Fundus photo
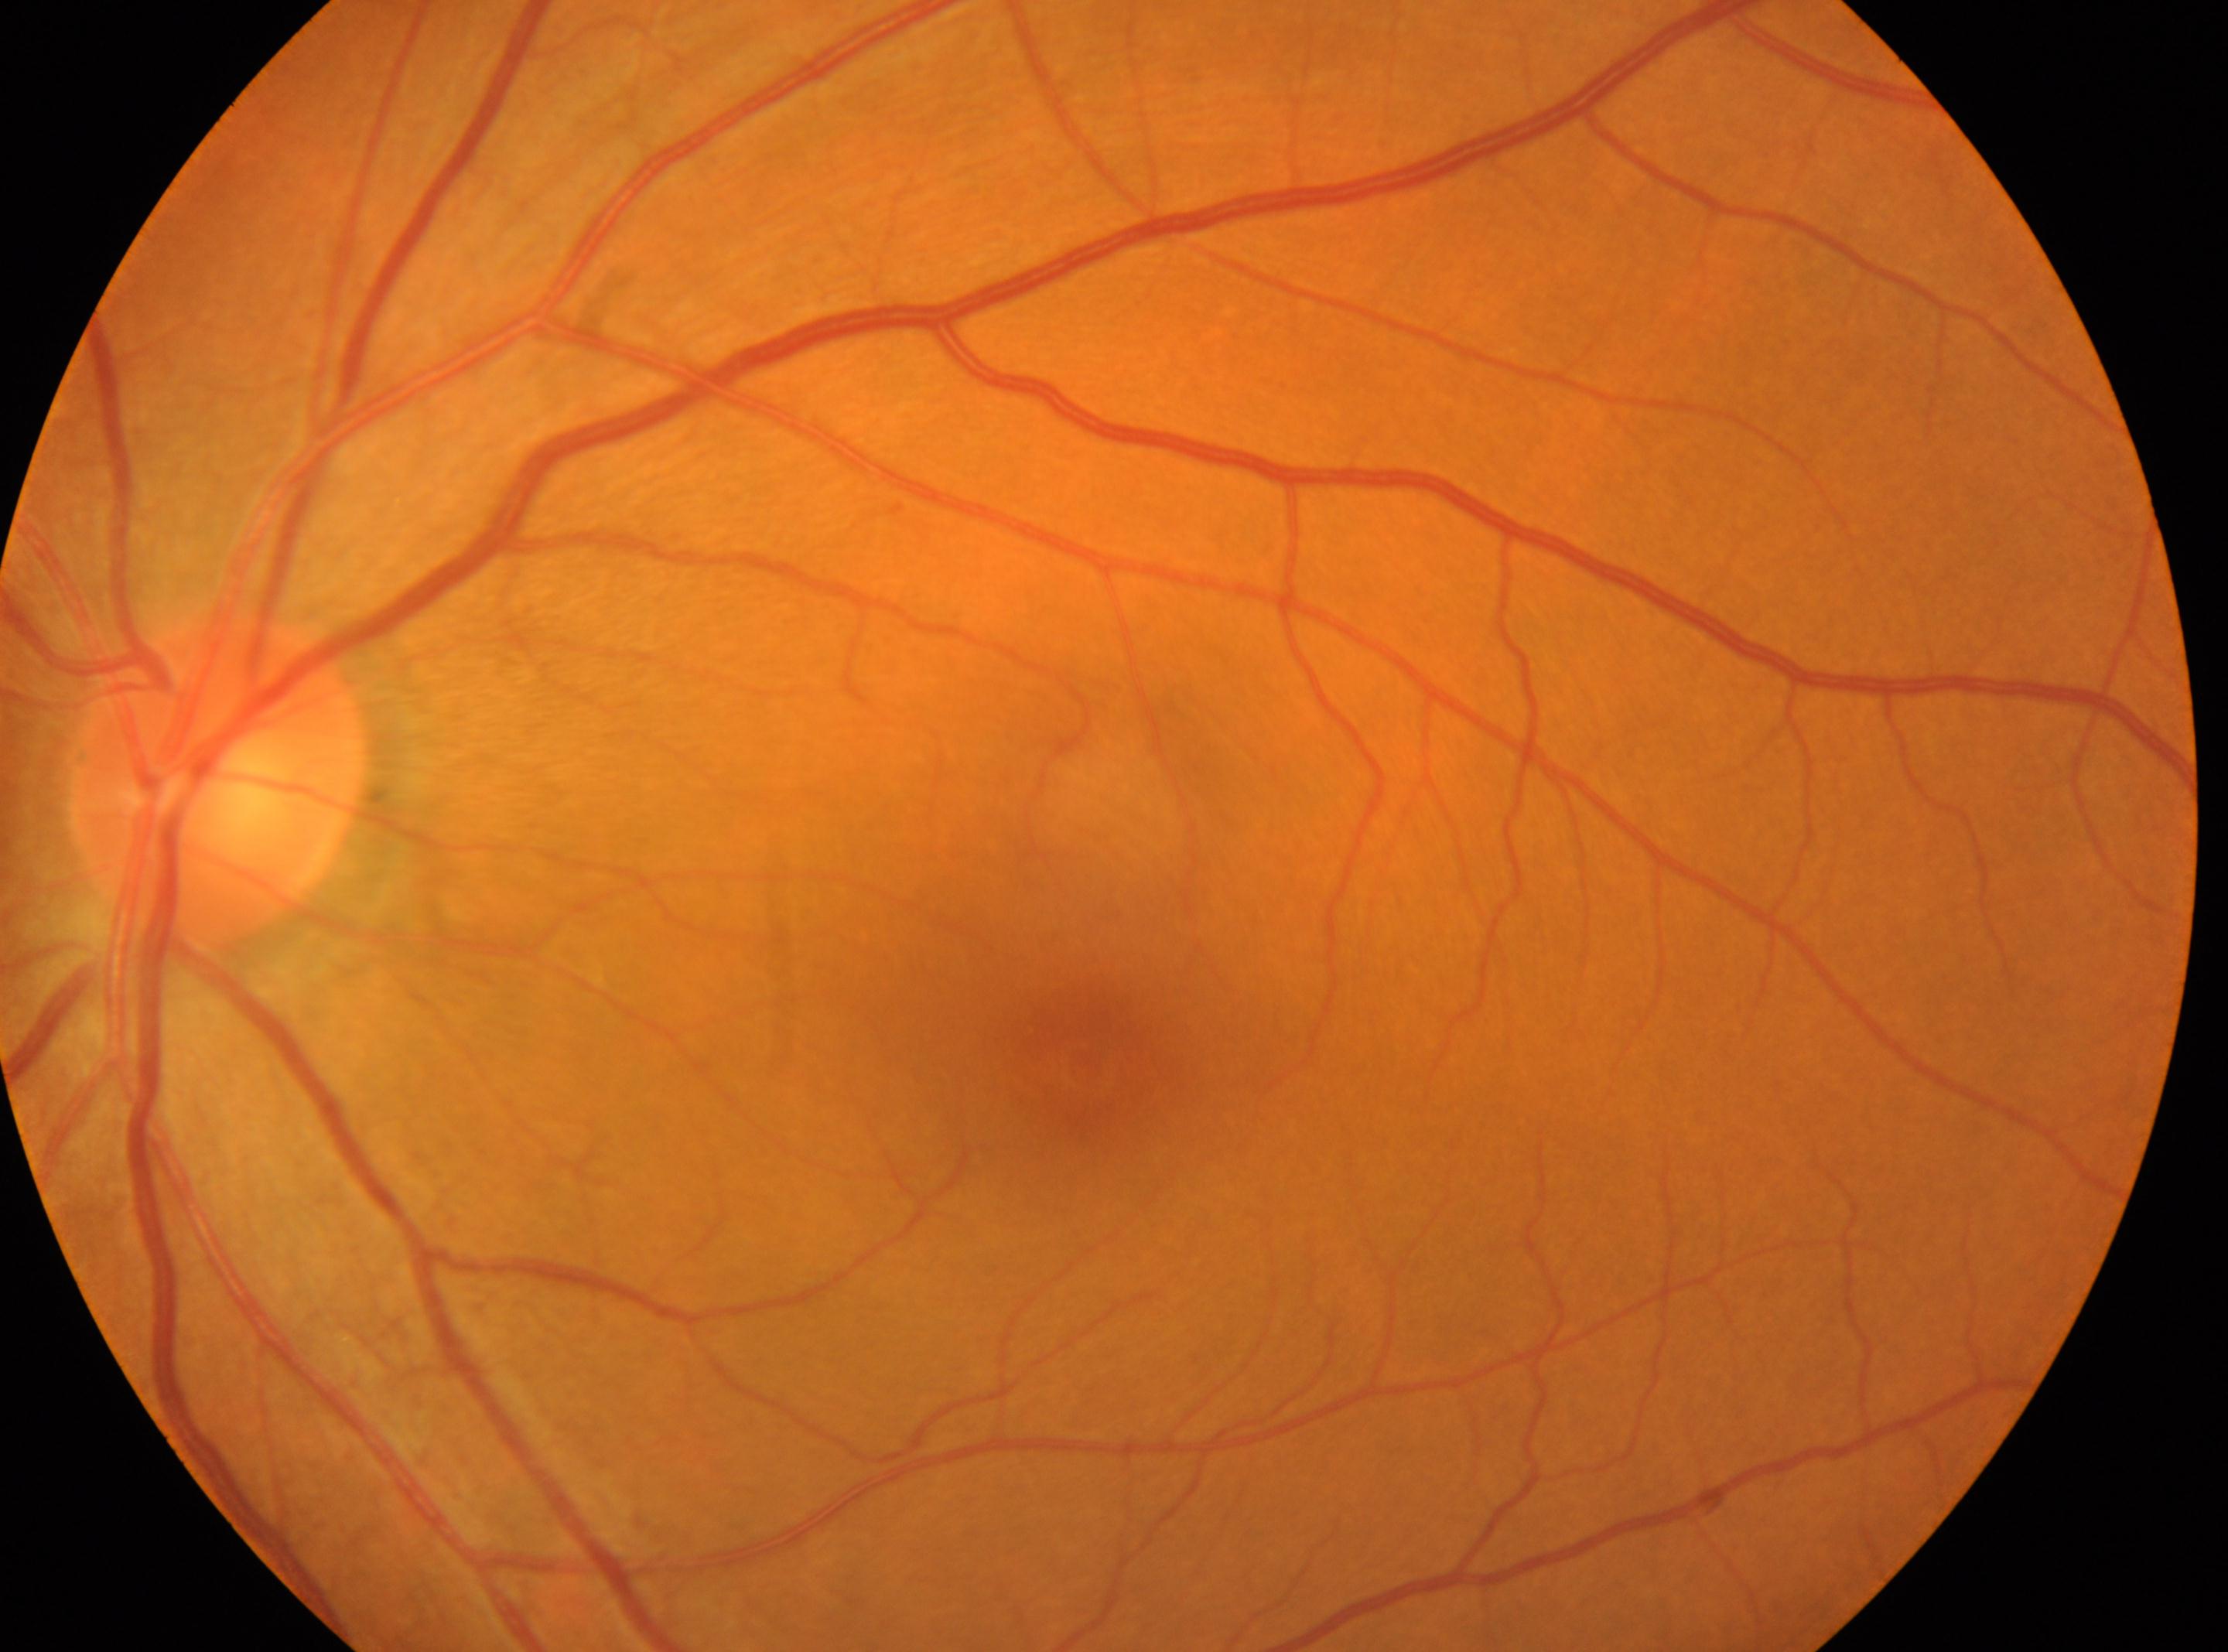

  fovea: 1078px, 1069px
  dr_impression: No apparent diabetic retinopathy
  dr_grade: no apparent retinopathy (grade 0)
  eye: left eye
  optic_disc: 215px, 780px